Infant wide-field fundus photograph · 1240 x 1240 pixels — 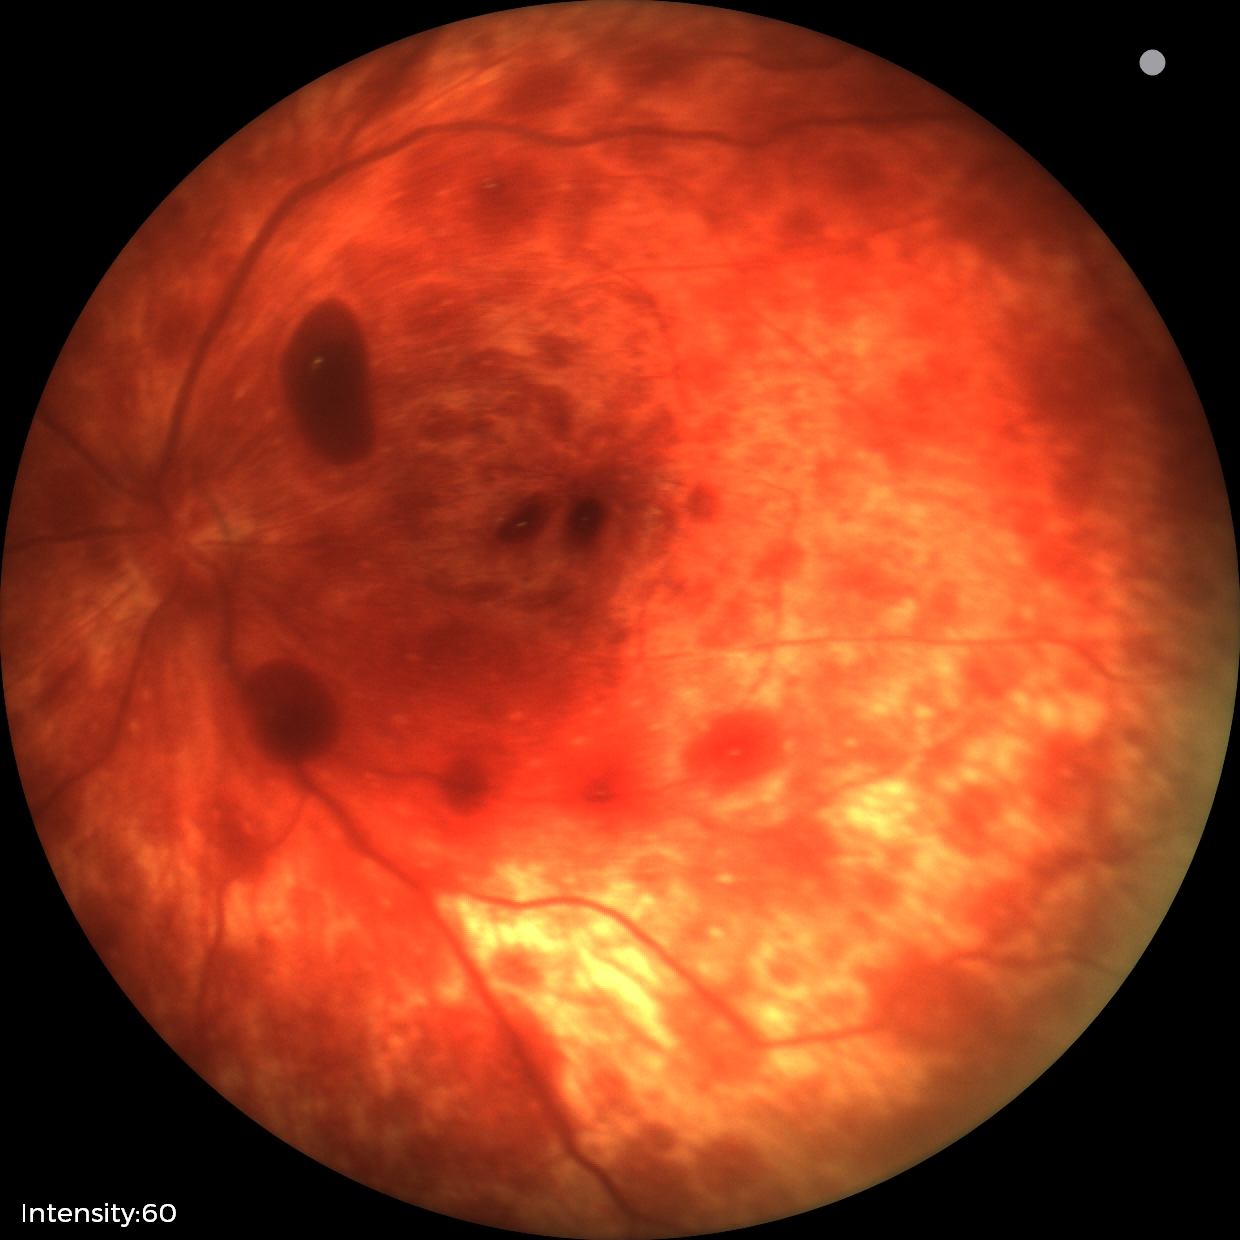
Screening series with retinal hemorrhages.